Posterior pole view. 2228x1652
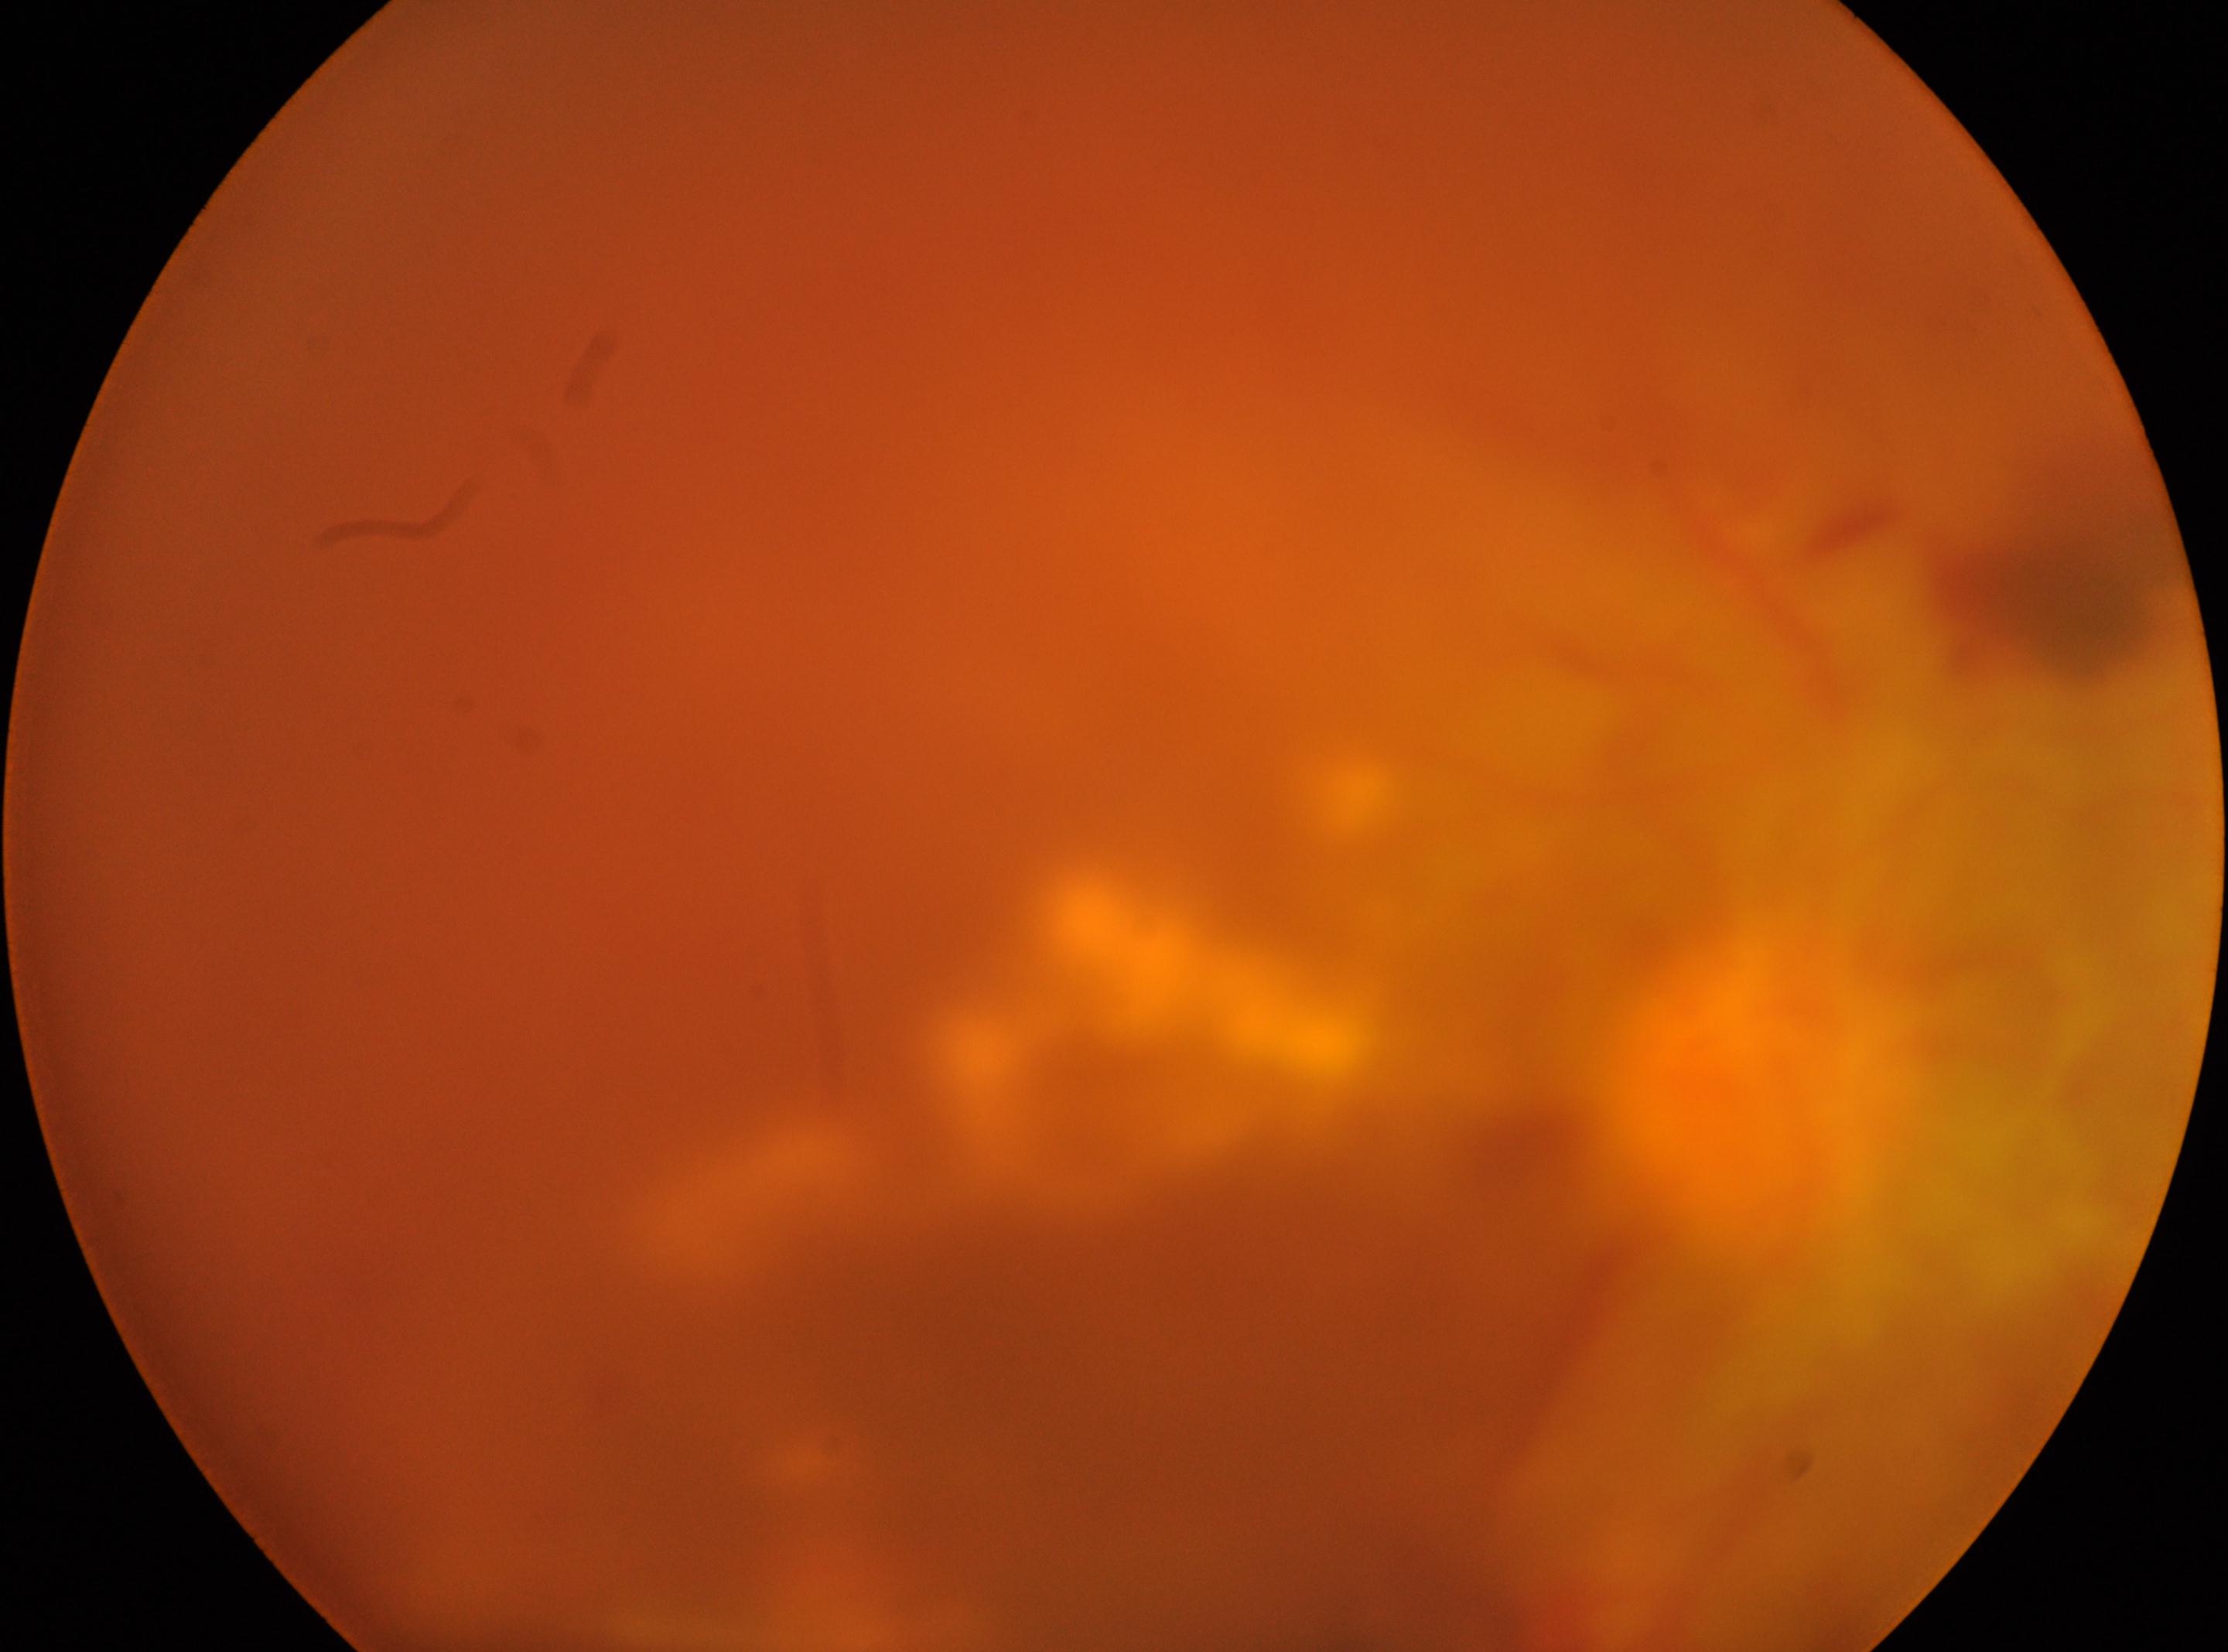
Q: Where is the optic disc?
A: (x: 1752, y: 1091)
Q: Diabetic retinopathy severity?
A: grade 4 (PDR)
Q: Locate the fovea.
A: (x: 1086, y: 1075)
Q: Which eye is imaged?
A: the right eye